45° FOV
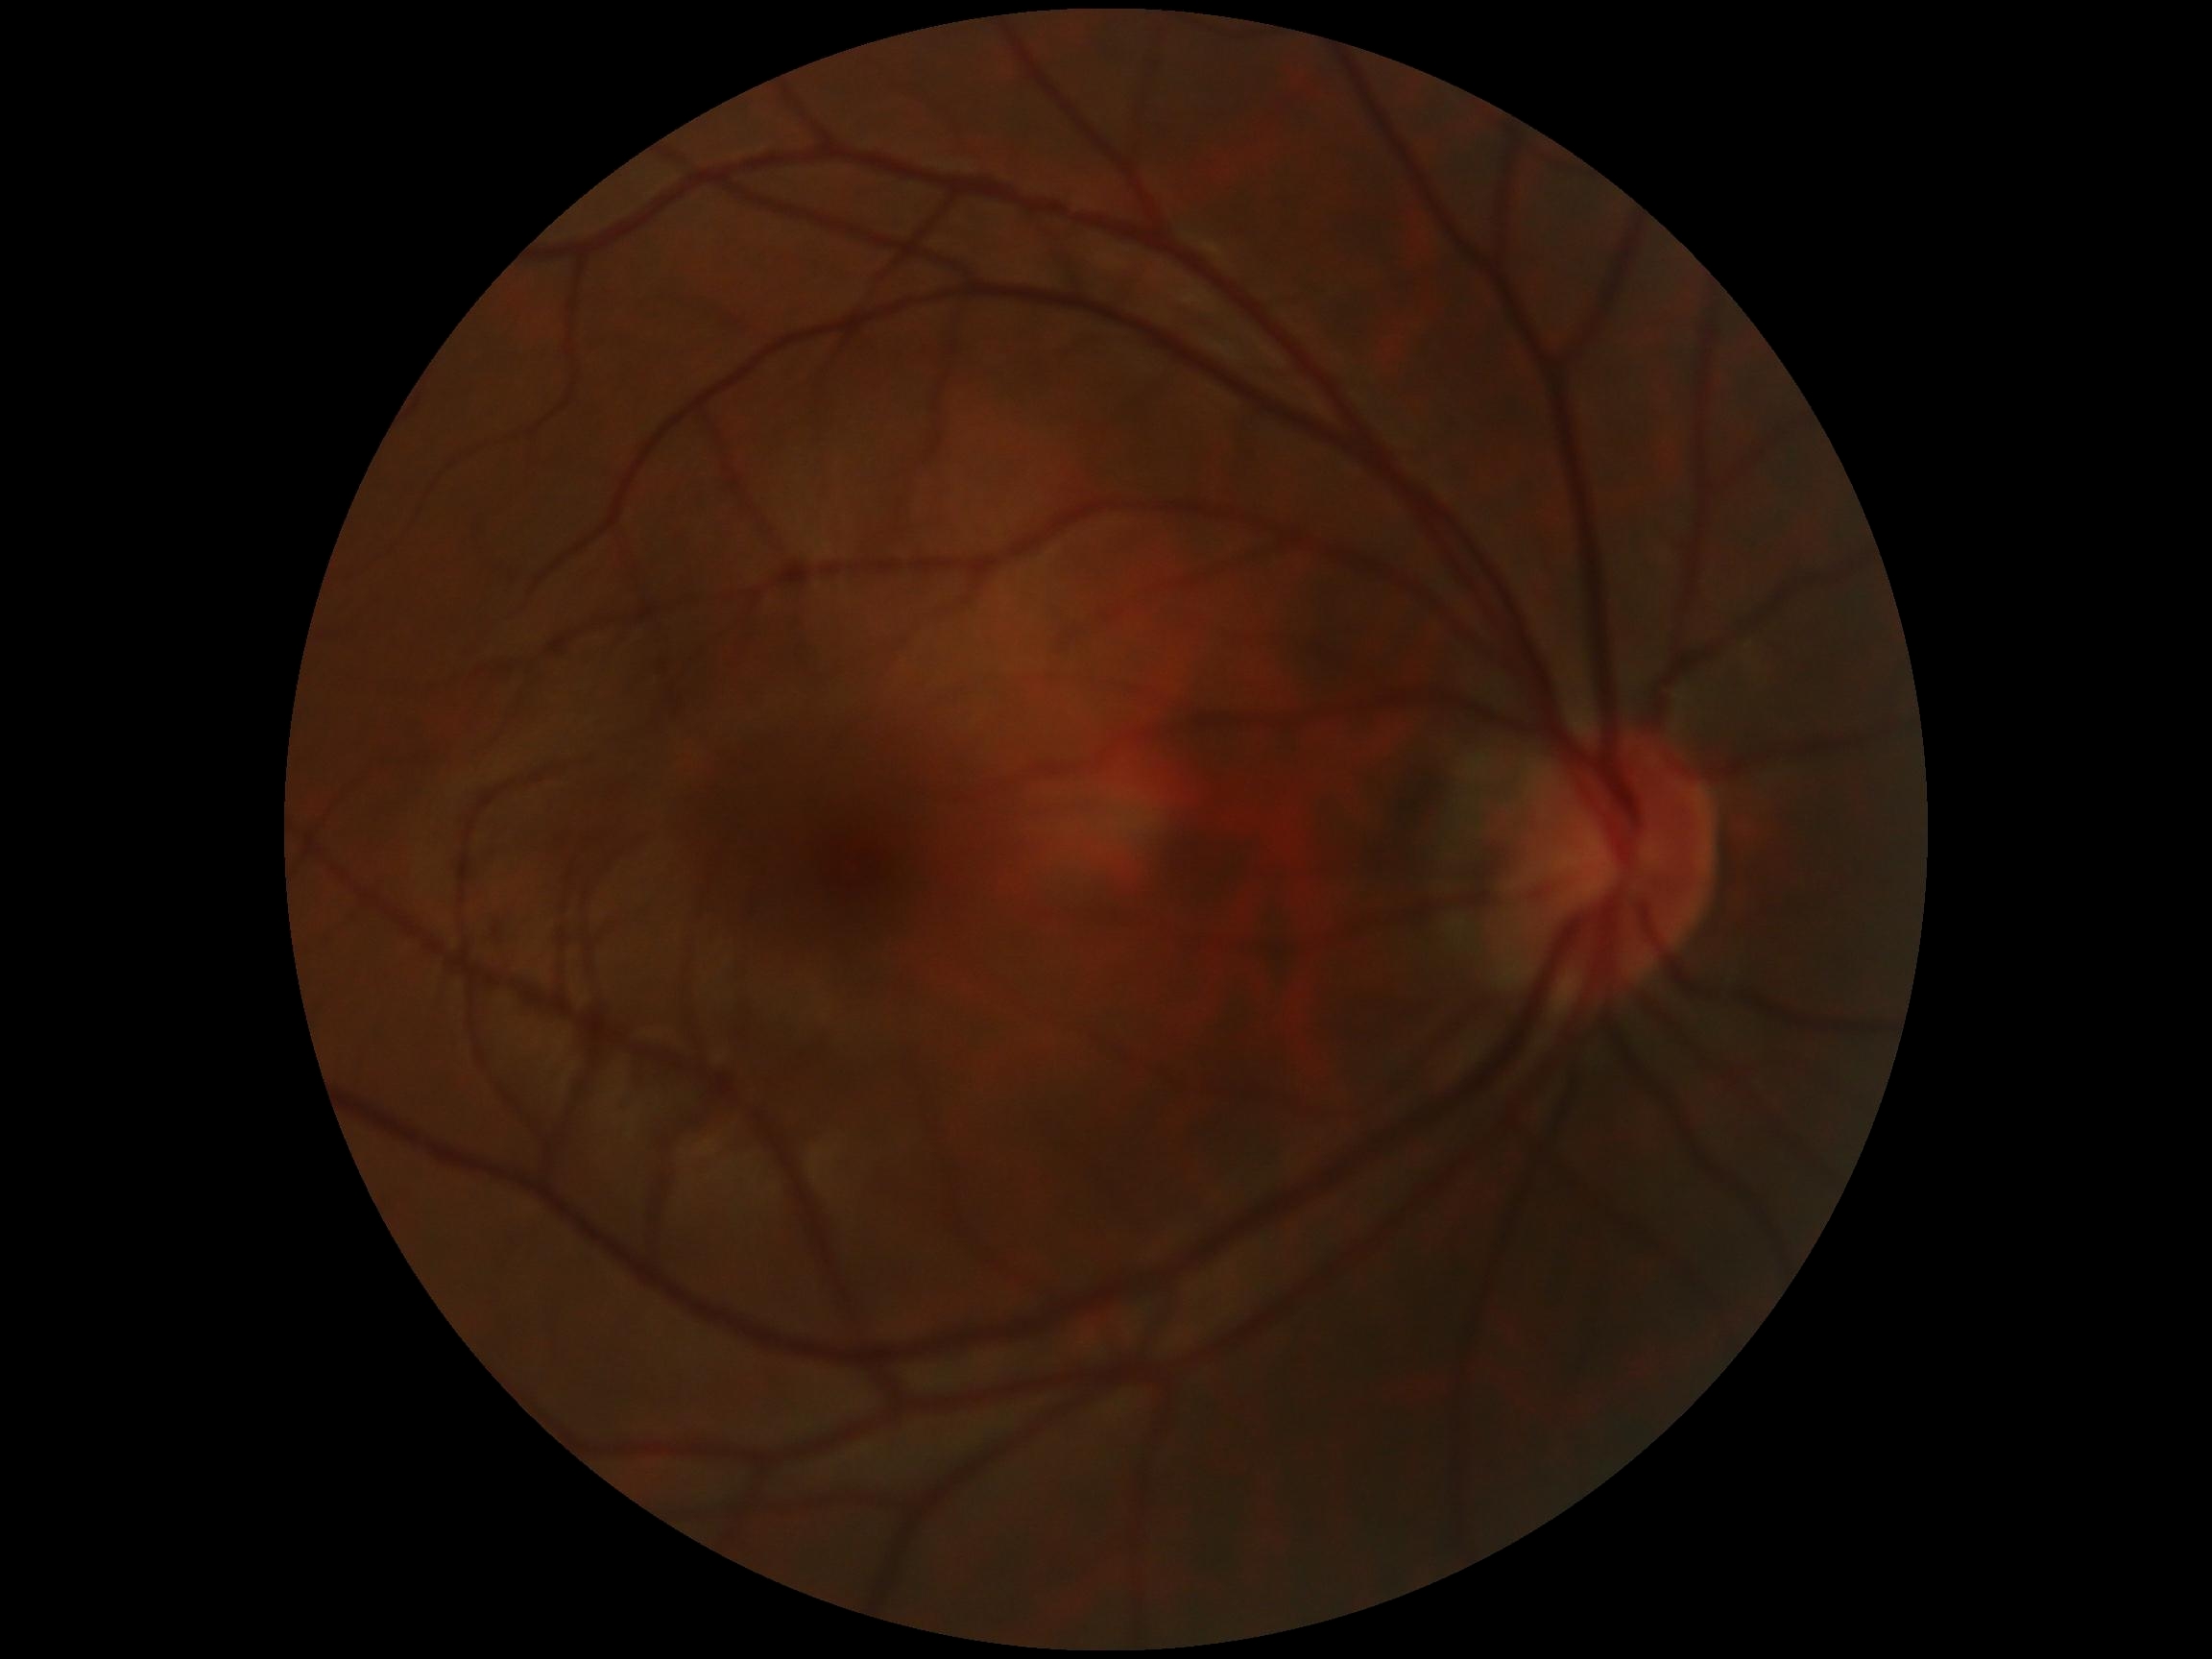 Diabetic retinopathy grade: no apparent retinopathy (0) — no visible signs of diabetic retinopathy.